45° FOV — 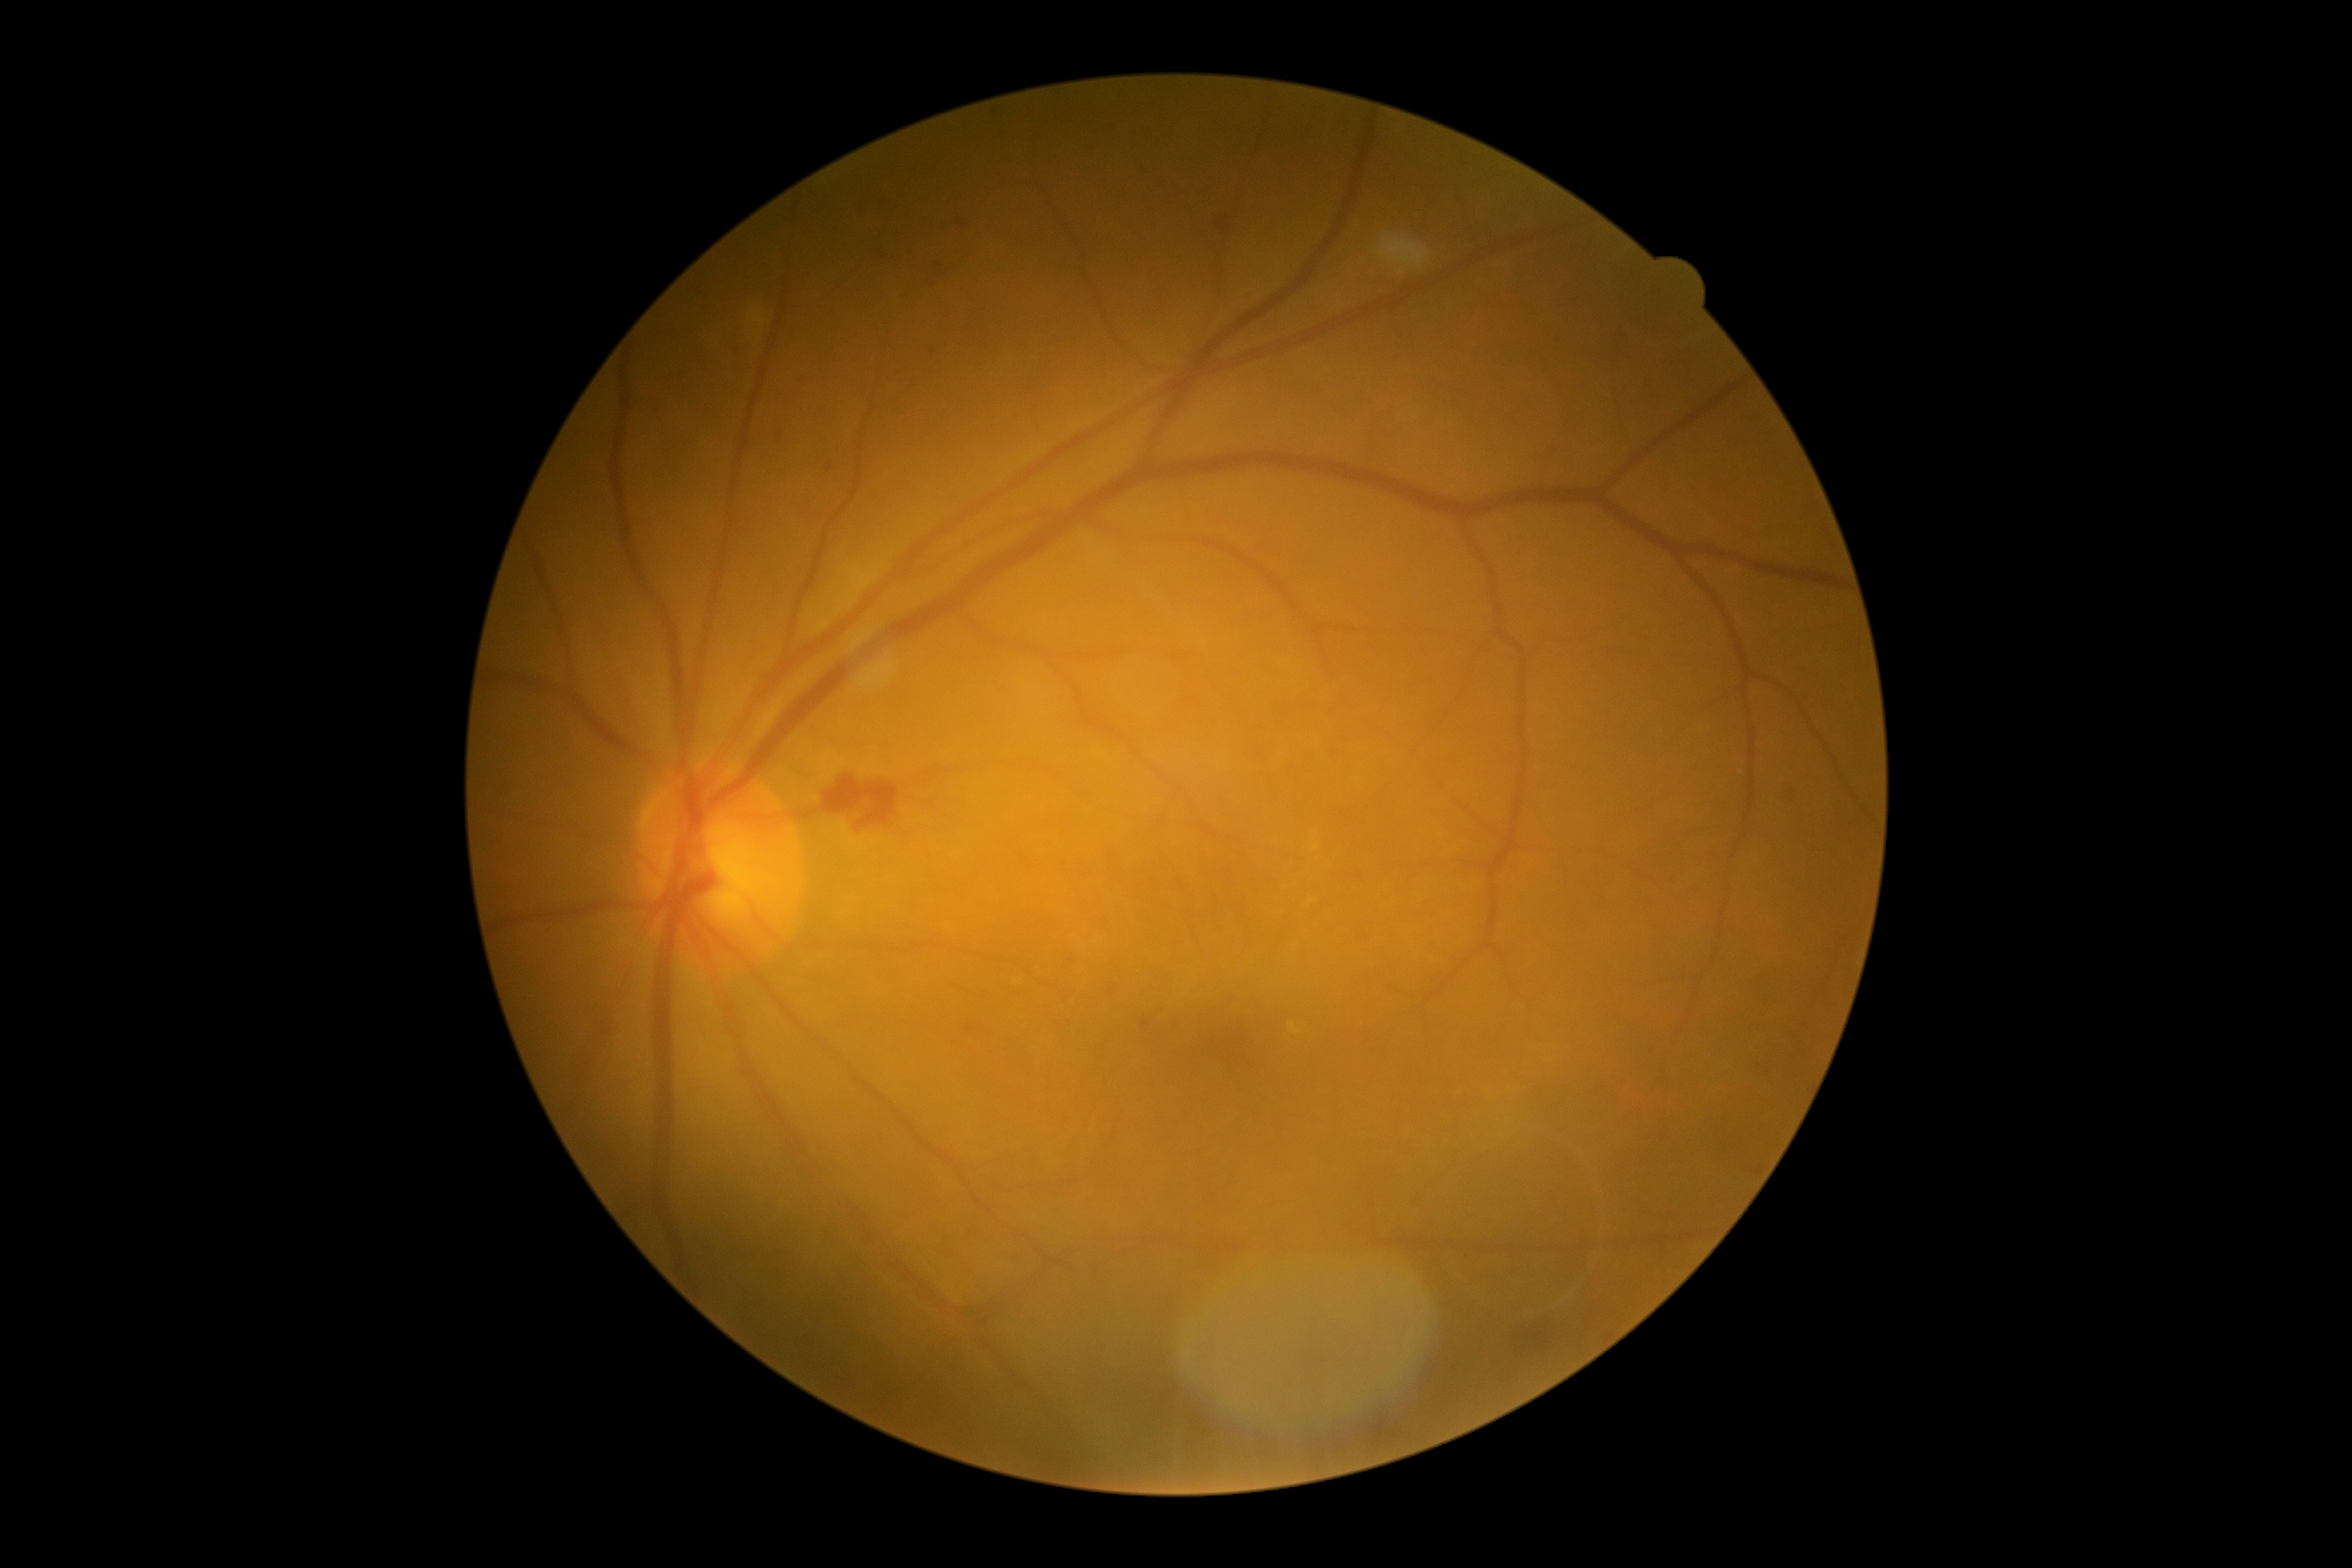 Retinopathy is moderate non-proliferative diabetic retinopathy (grade 2).